Mydriatic (tropicamide and phenylephrine) · posterior pole field covering the optic disc and macula · image size 2228x1652.
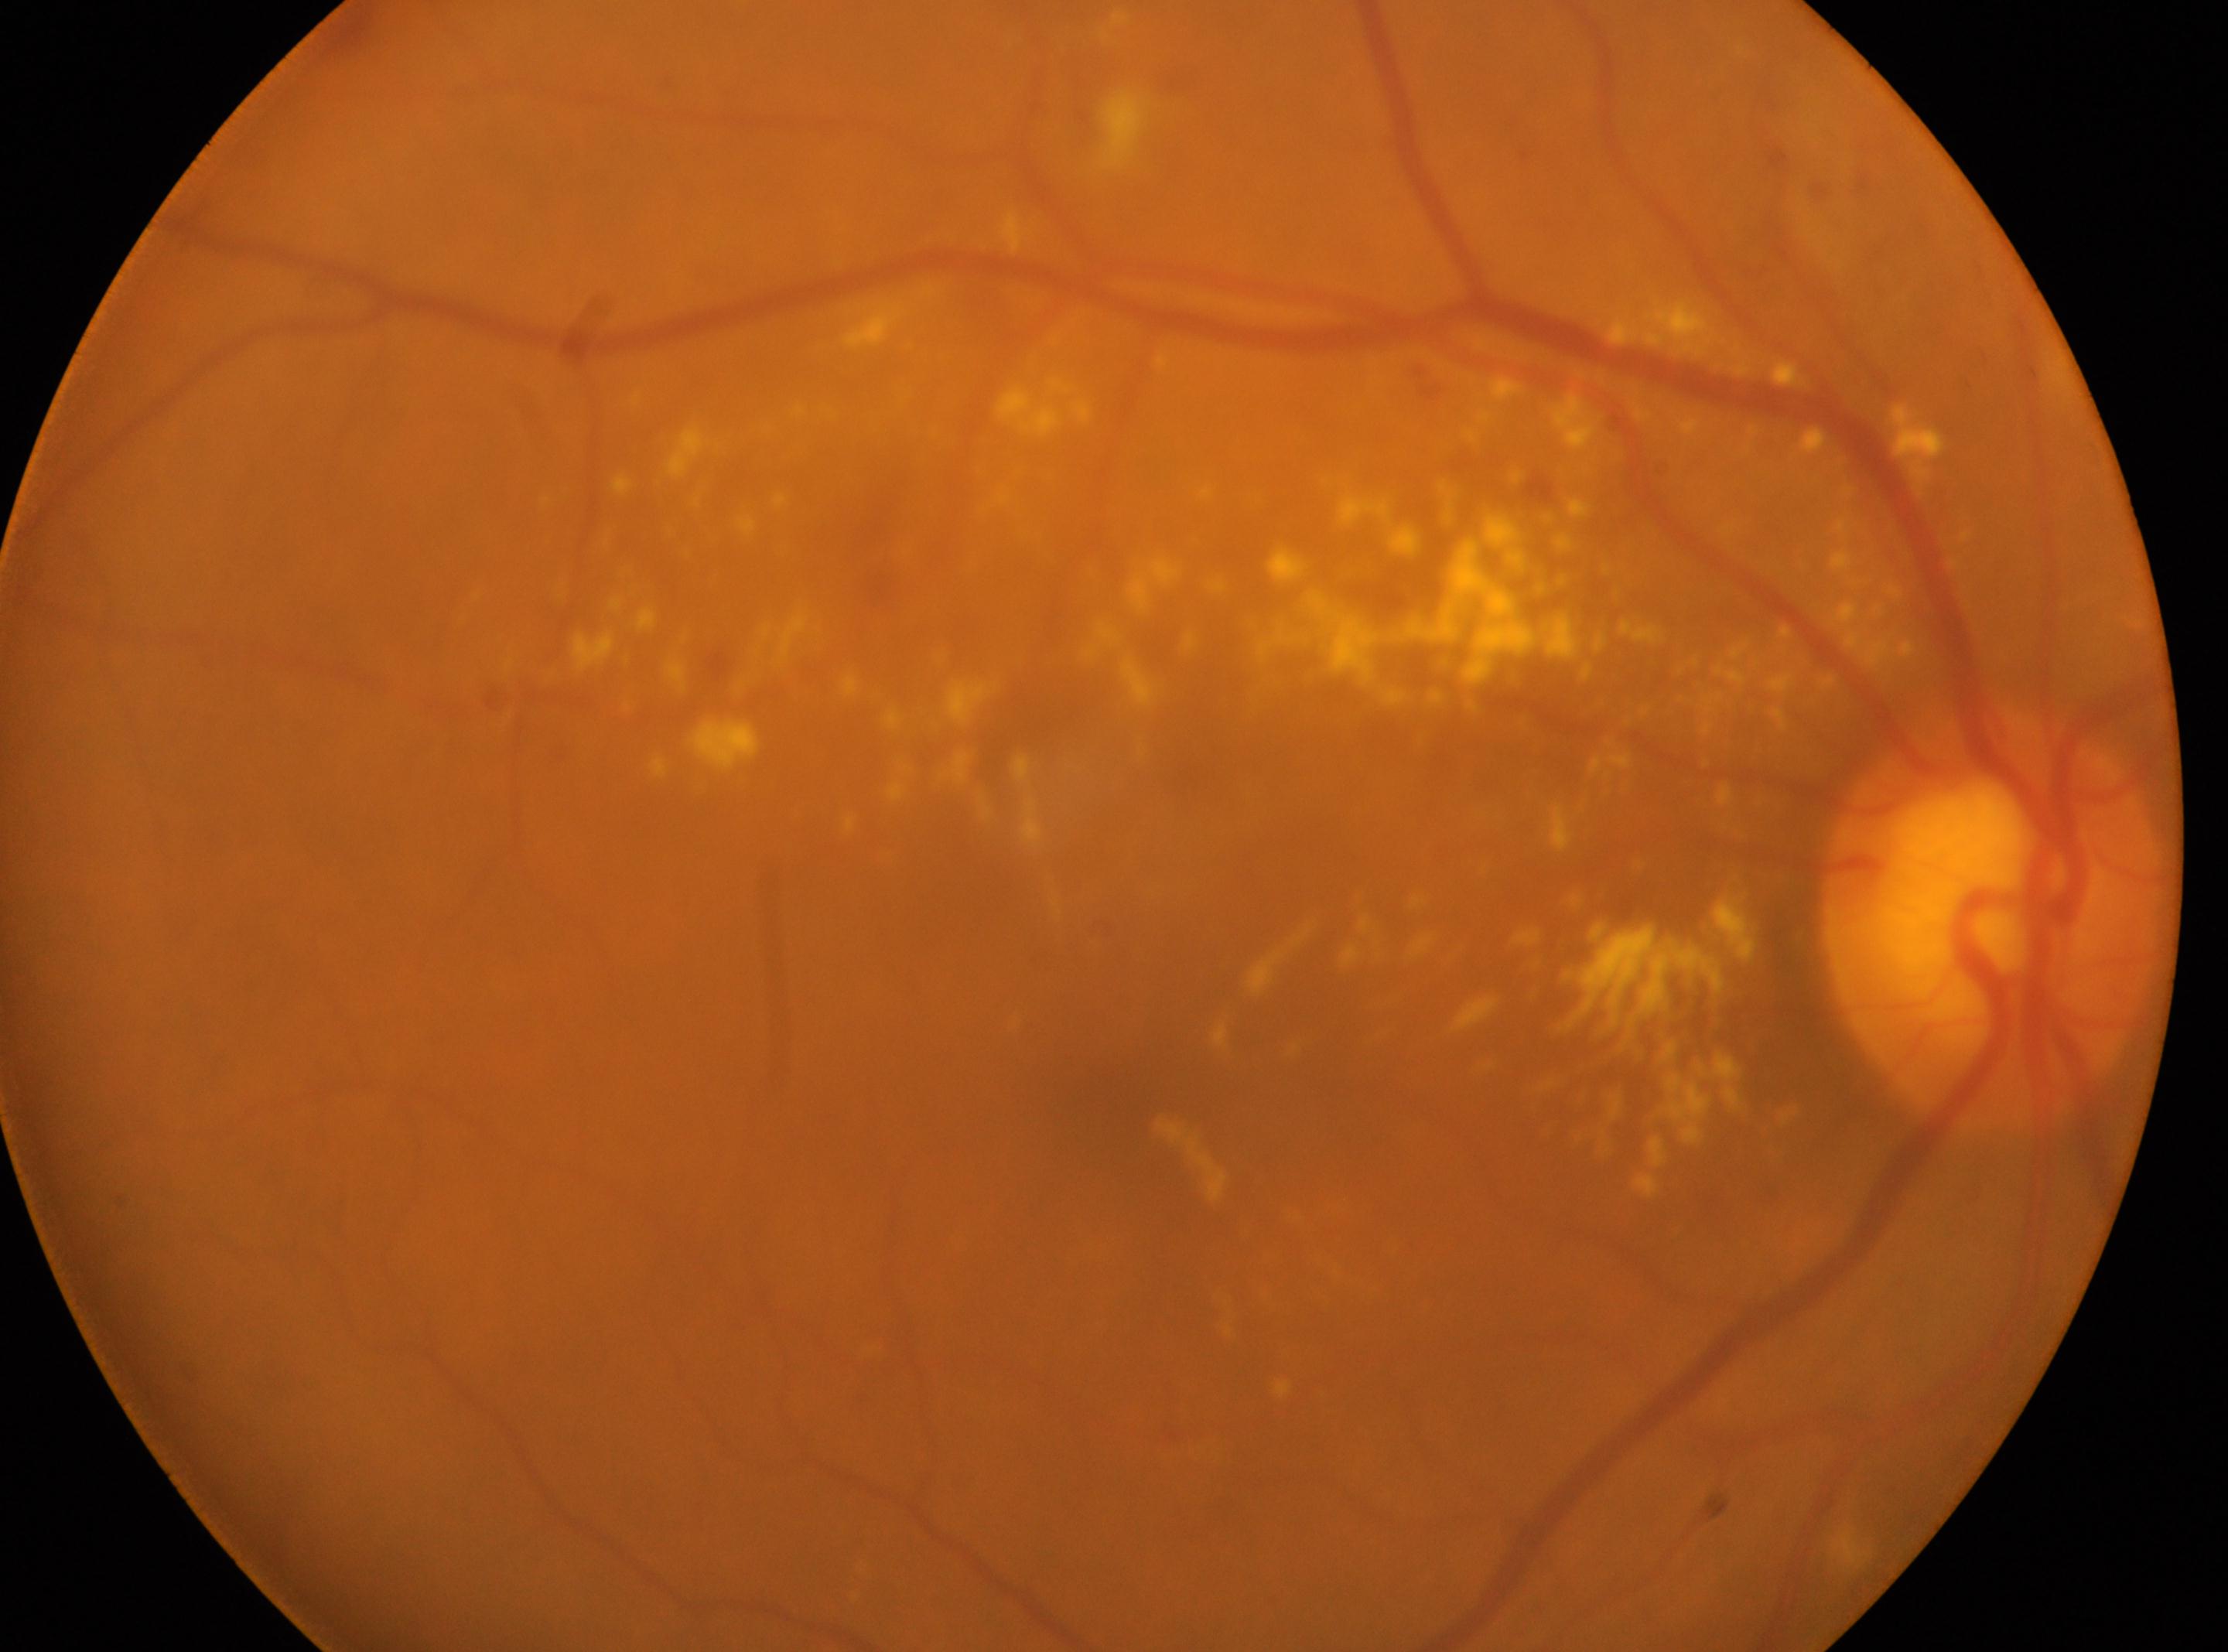
{"eye": "the right eye", "optic_disc": "1988, 920", "fovea": "1122, 1098", "dr_grade": "2"}